2352 x 1568 pixels:
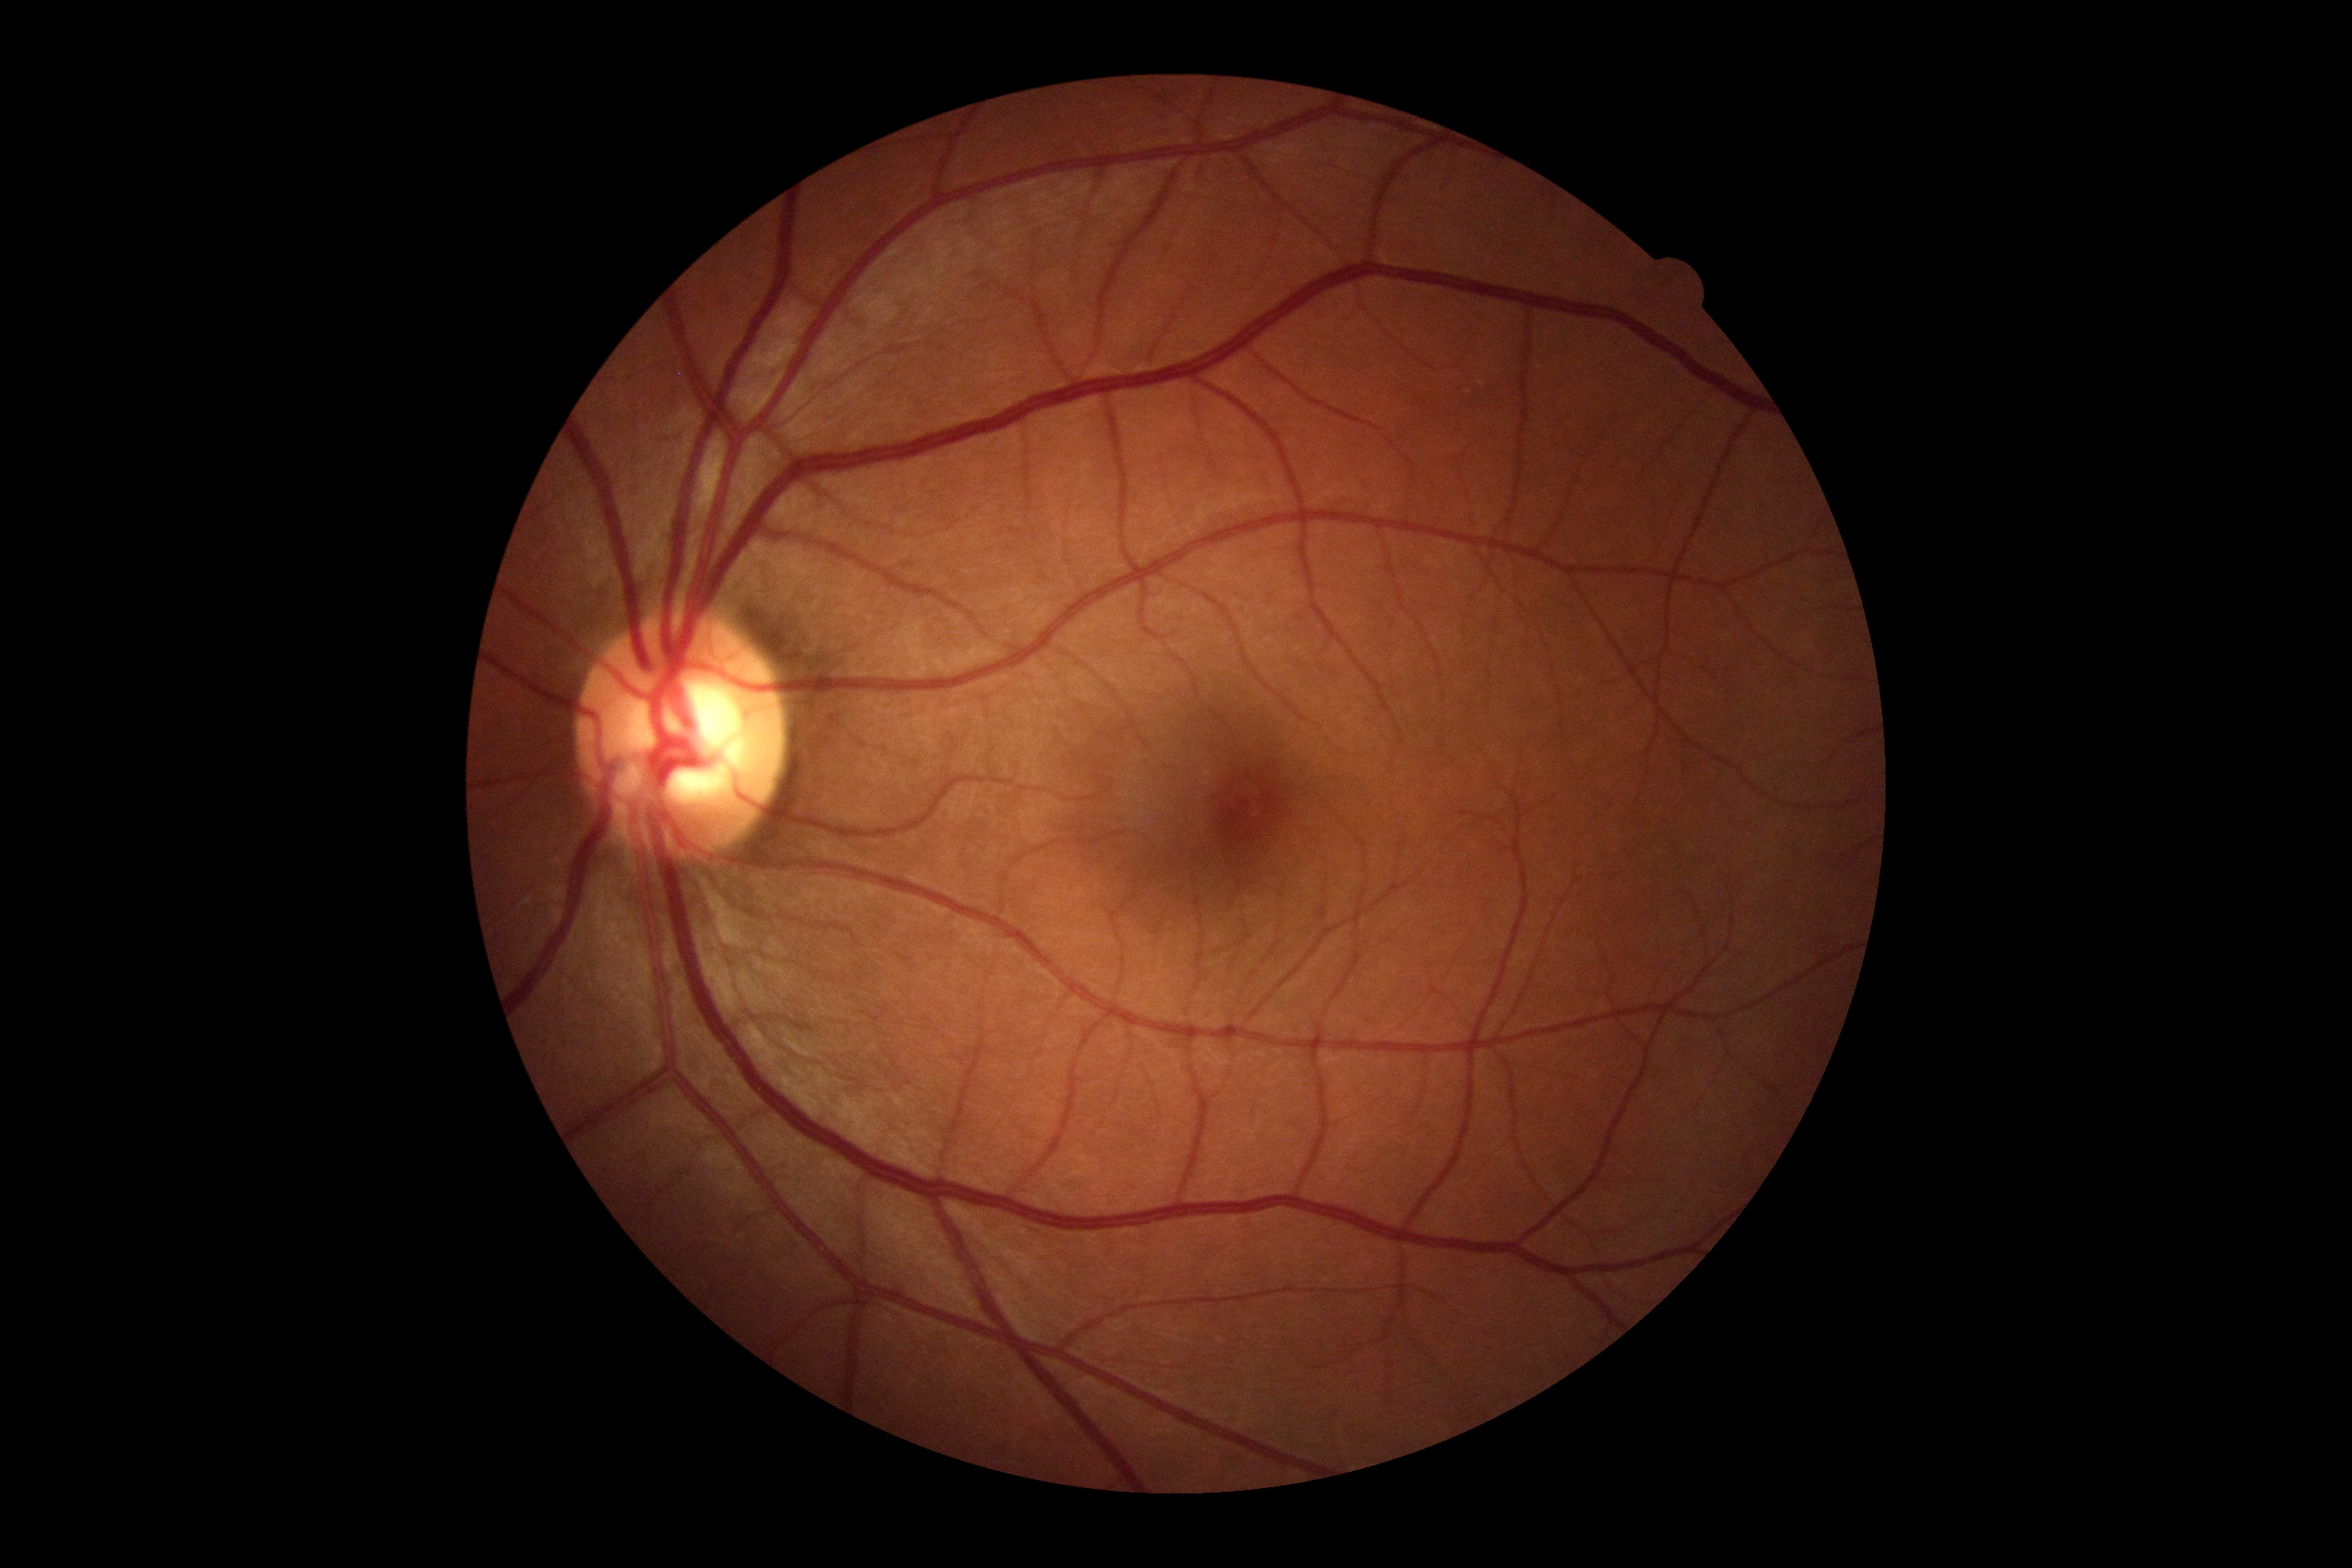 No DR findings. Diabetic retinopathy (DR): no apparent diabetic retinopathy (grade 0).